Color fundus photograph, FOV: 45 degrees, 1932 x 1916 pixels:
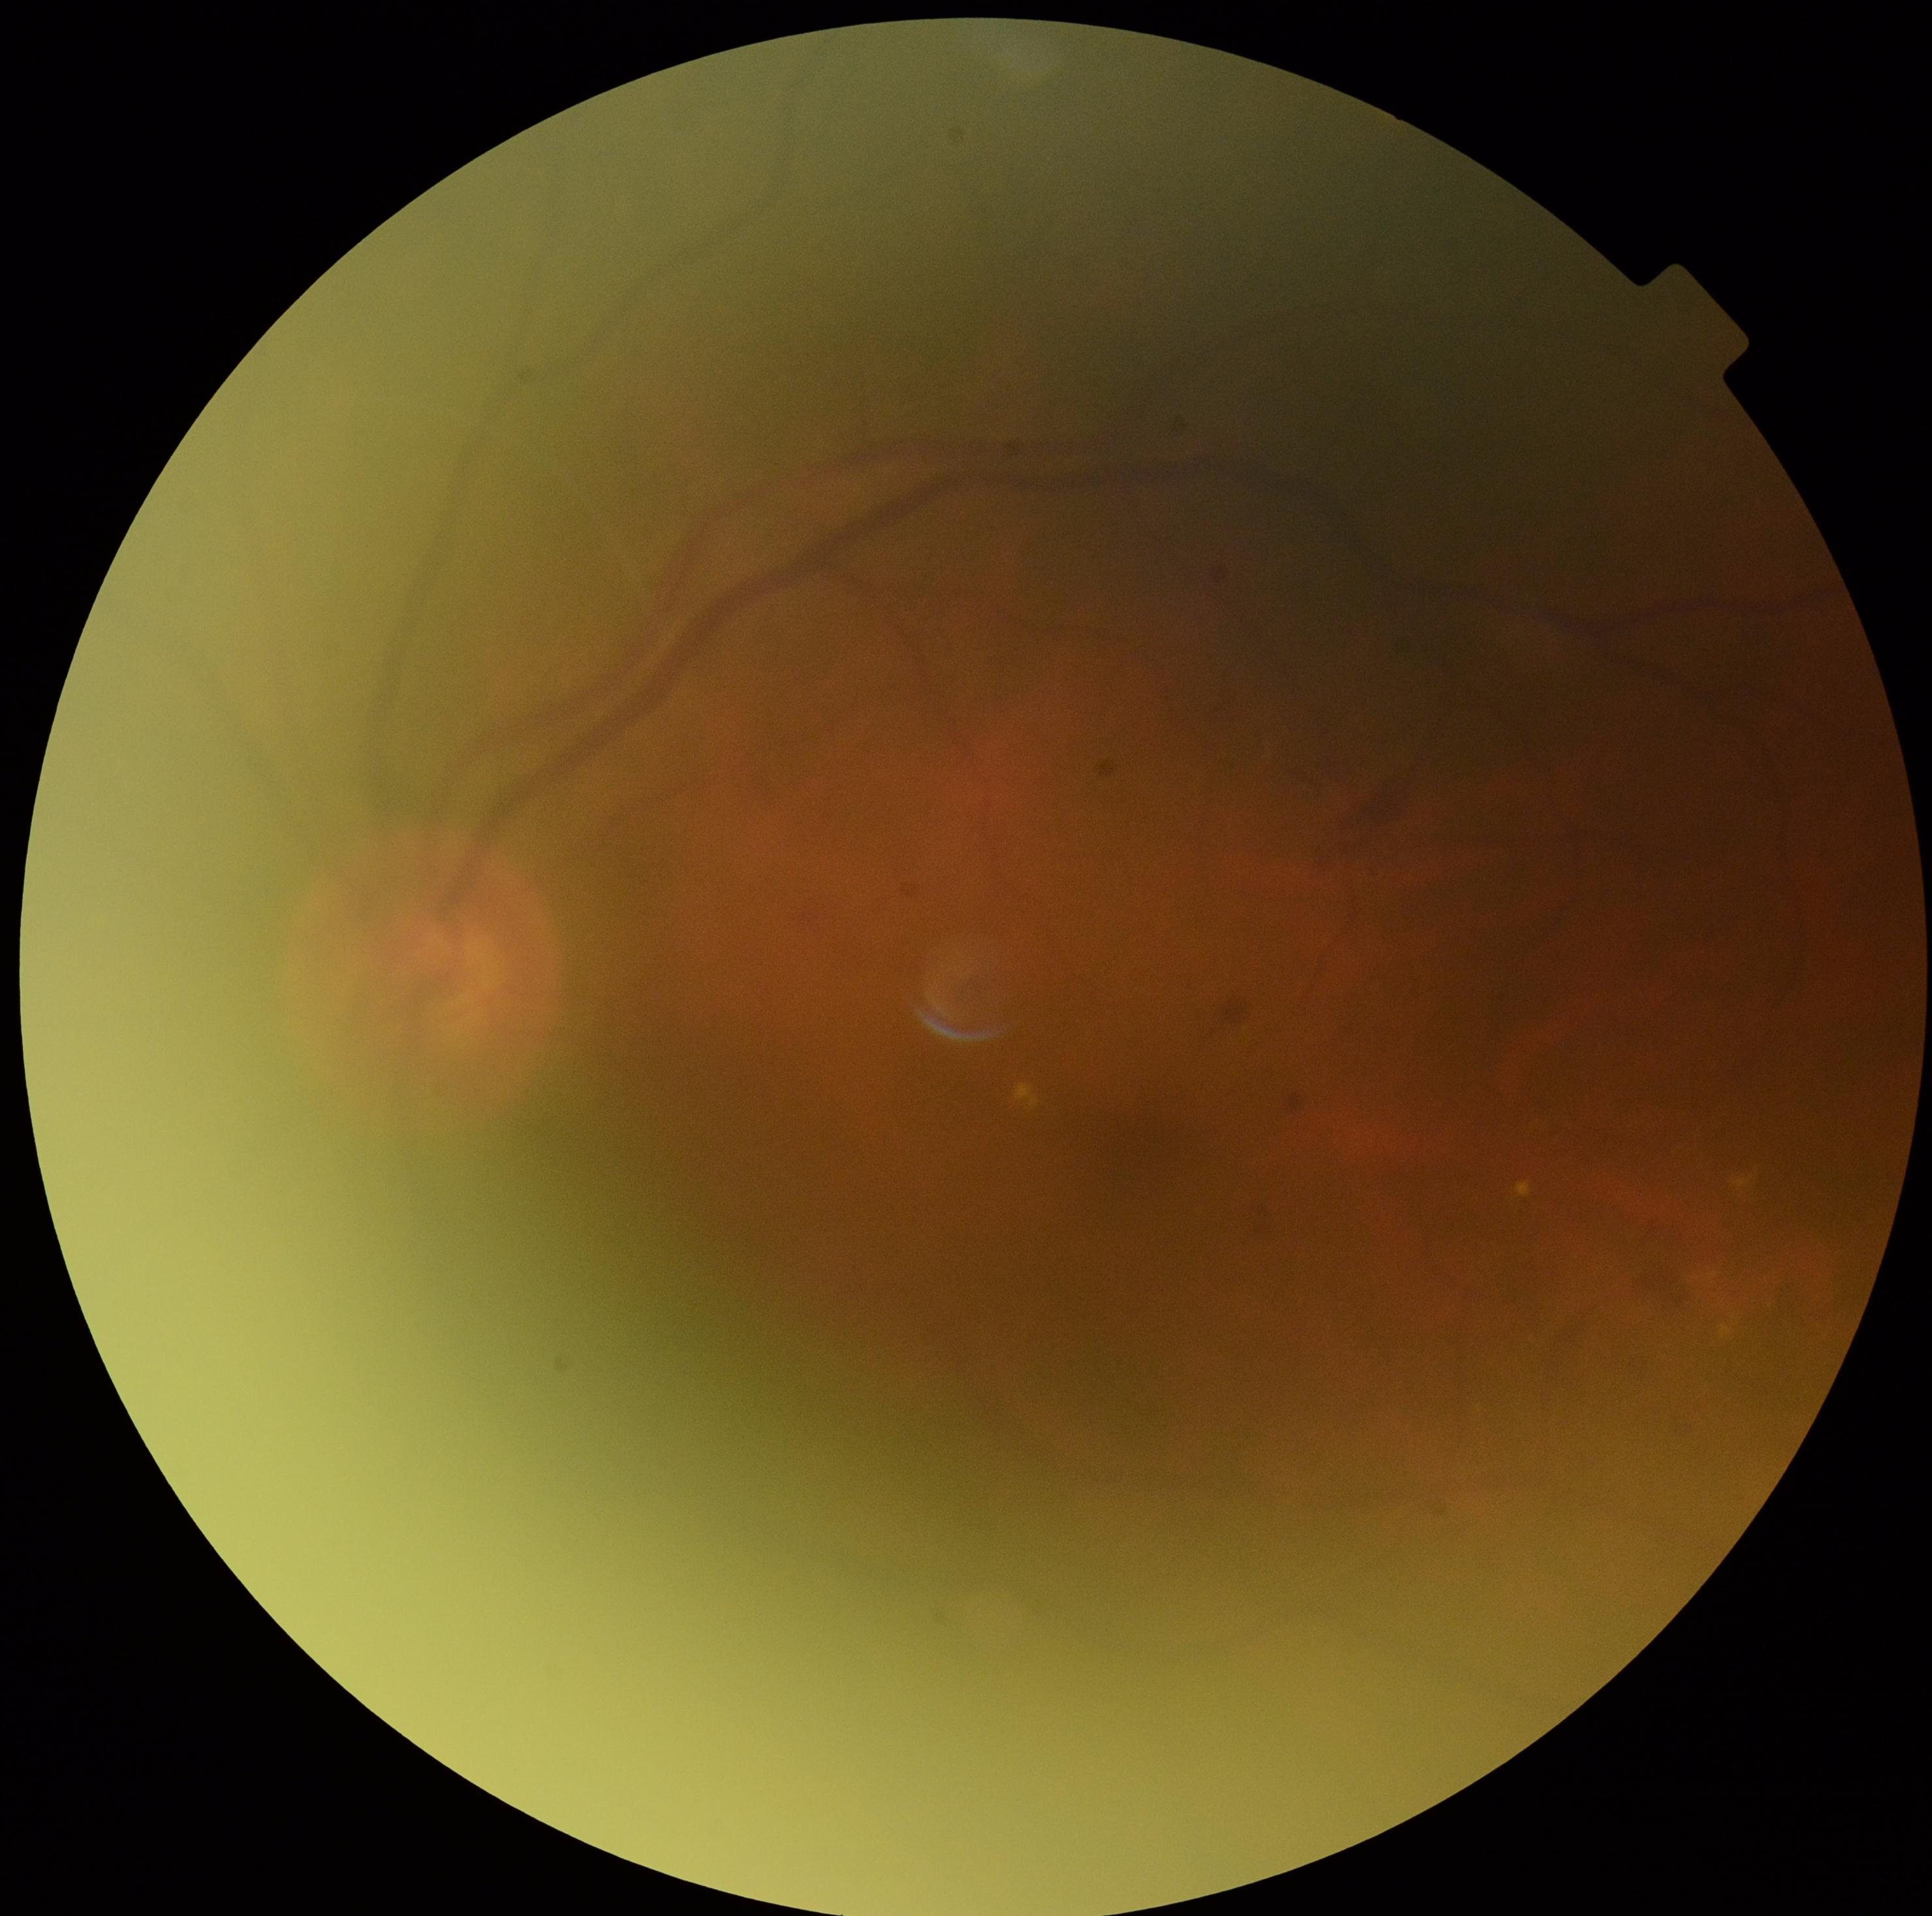 diabetic retinopathy grade@2; DR class@non-proliferative diabetic retinopathy.